Macula at the center of the field.
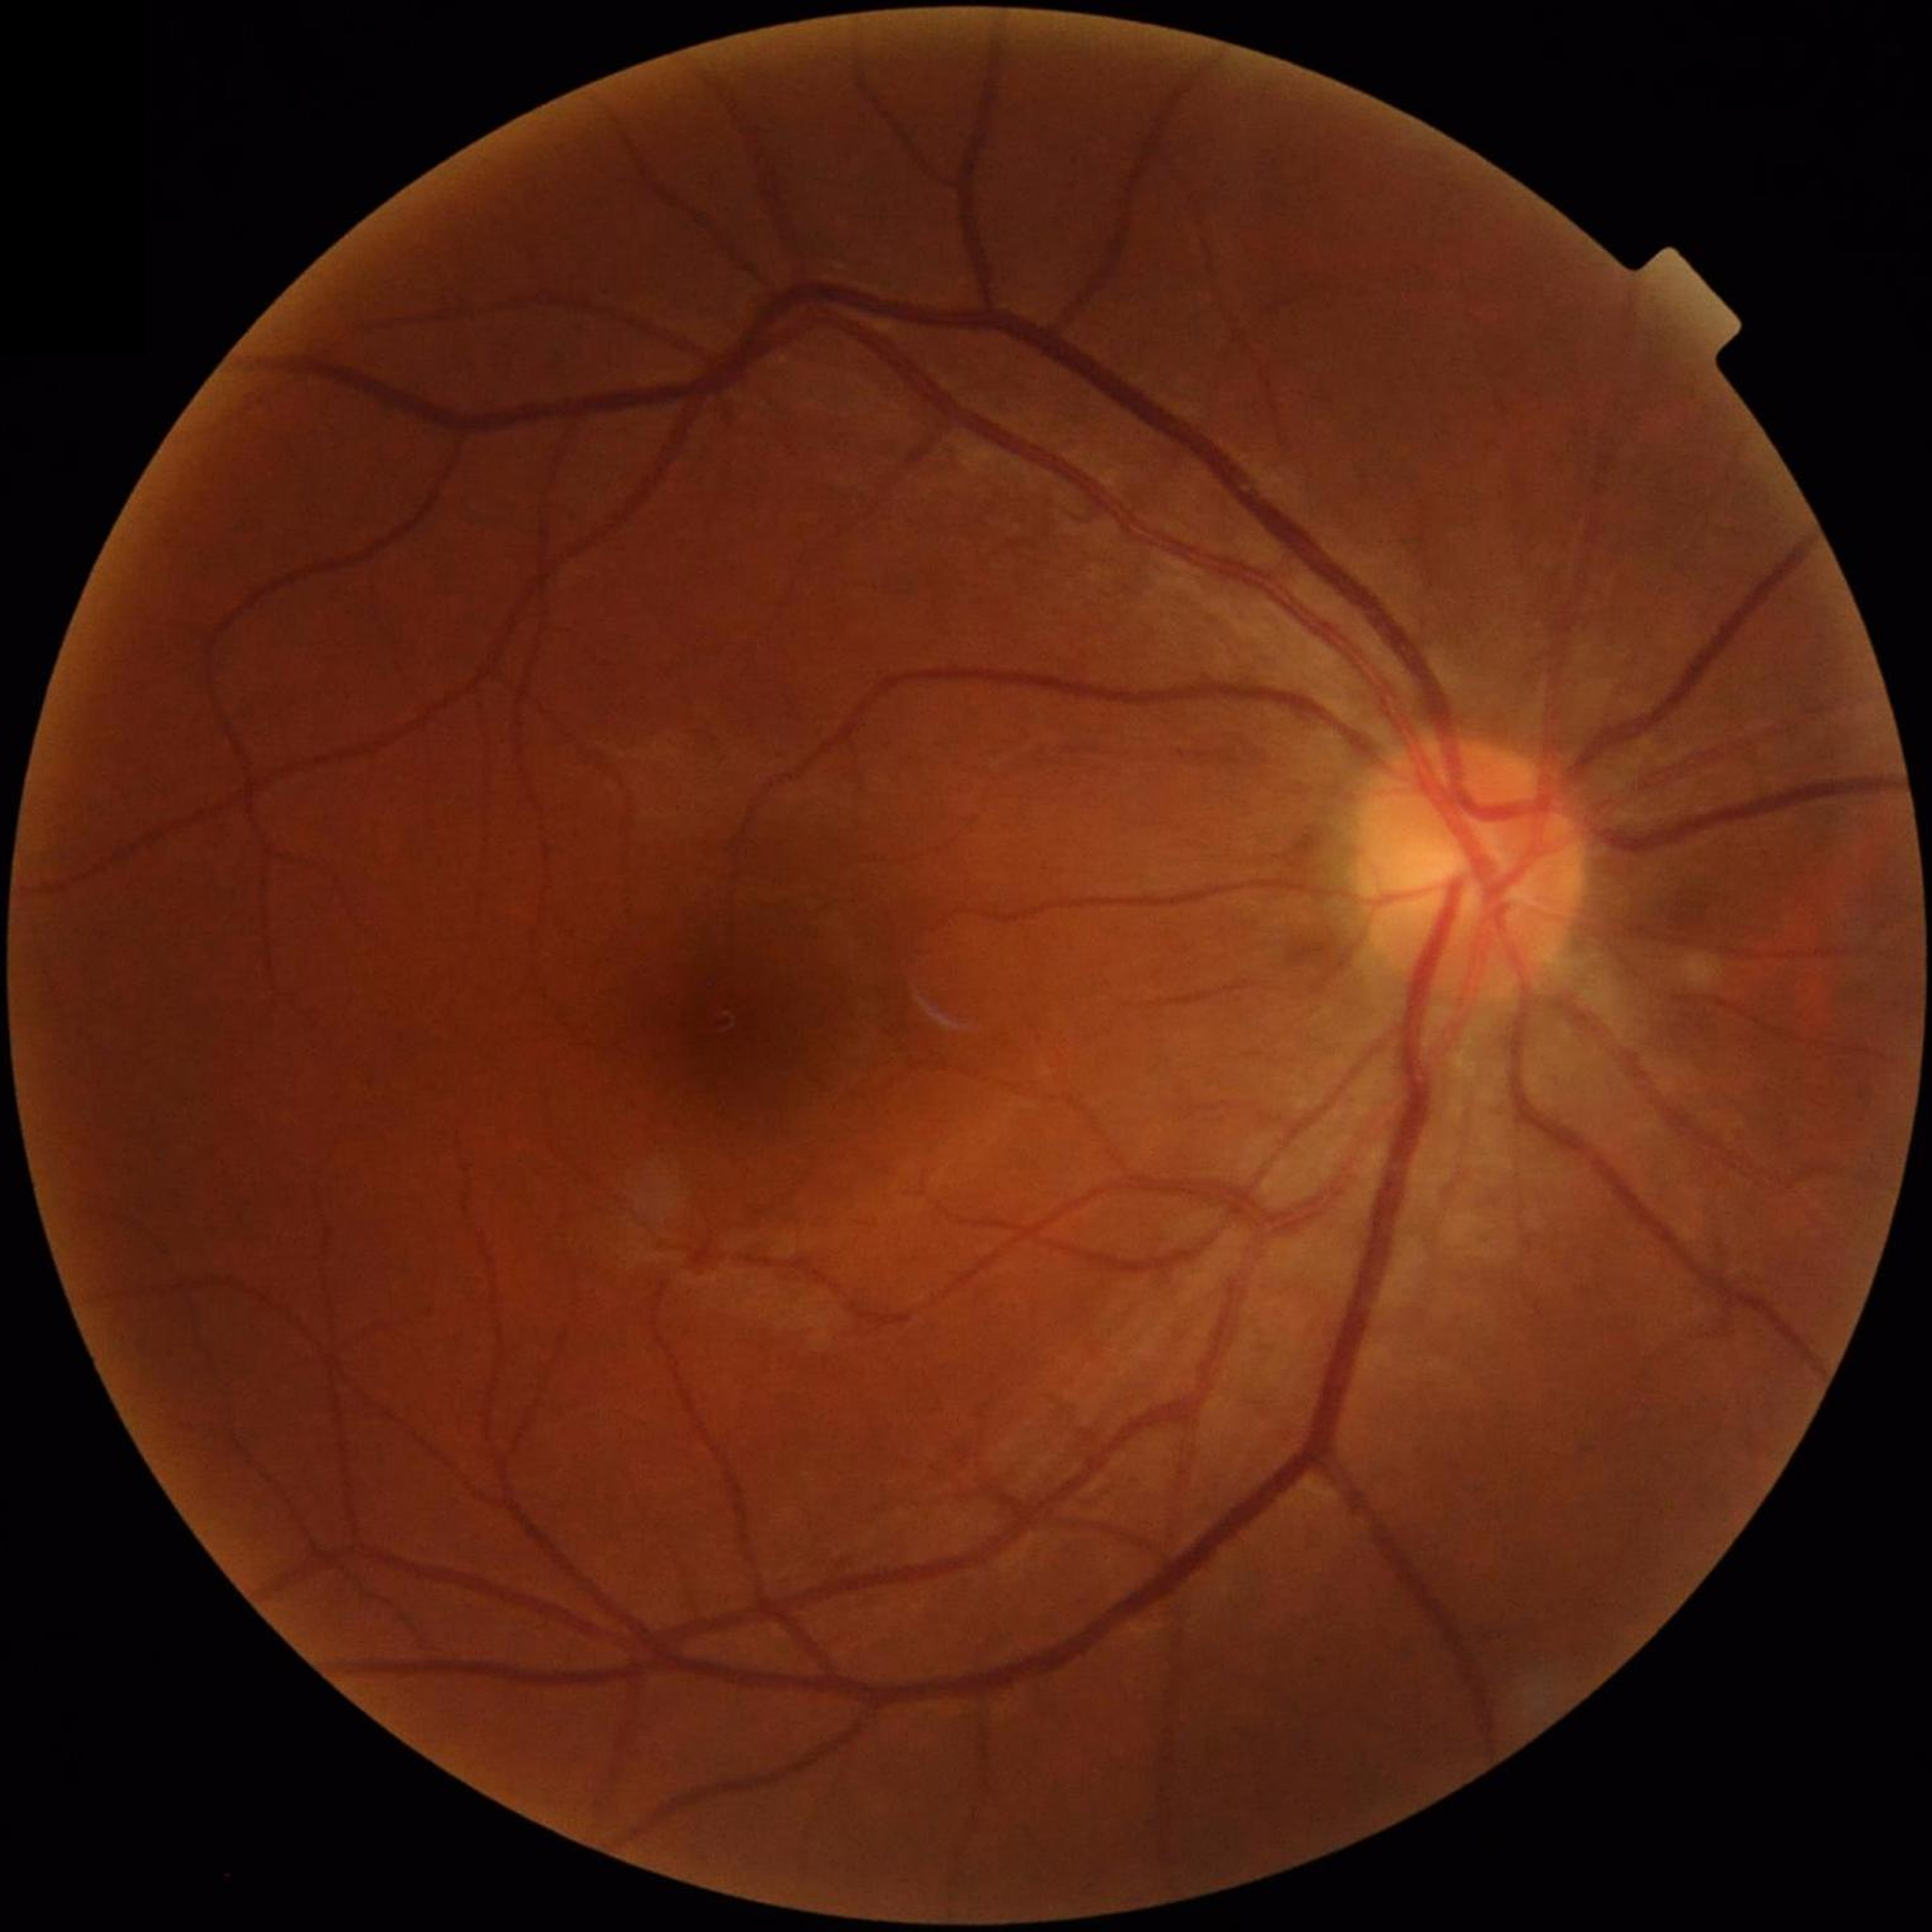

Disease class: no AMD, DR, or glaucomatous findings | Quality: illumination and color satisfactory, contrast adequate, no blur.